Wide-field fundus photograph from neonatal ROP screening. 640x480. Camera: Clarity RetCam 3 (130° FOV)
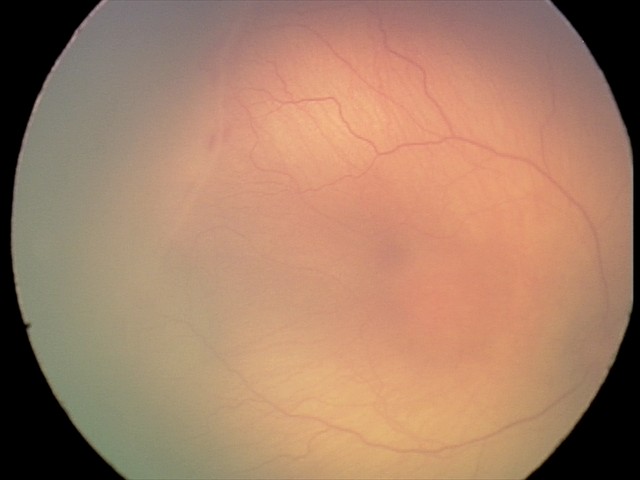
Examination diagnosed as ROP stage 1 — demarcation line between vascular and avascular retina.